Natus RetCam Envision, 130° FOV · wide-field fundus photograph of an infant: 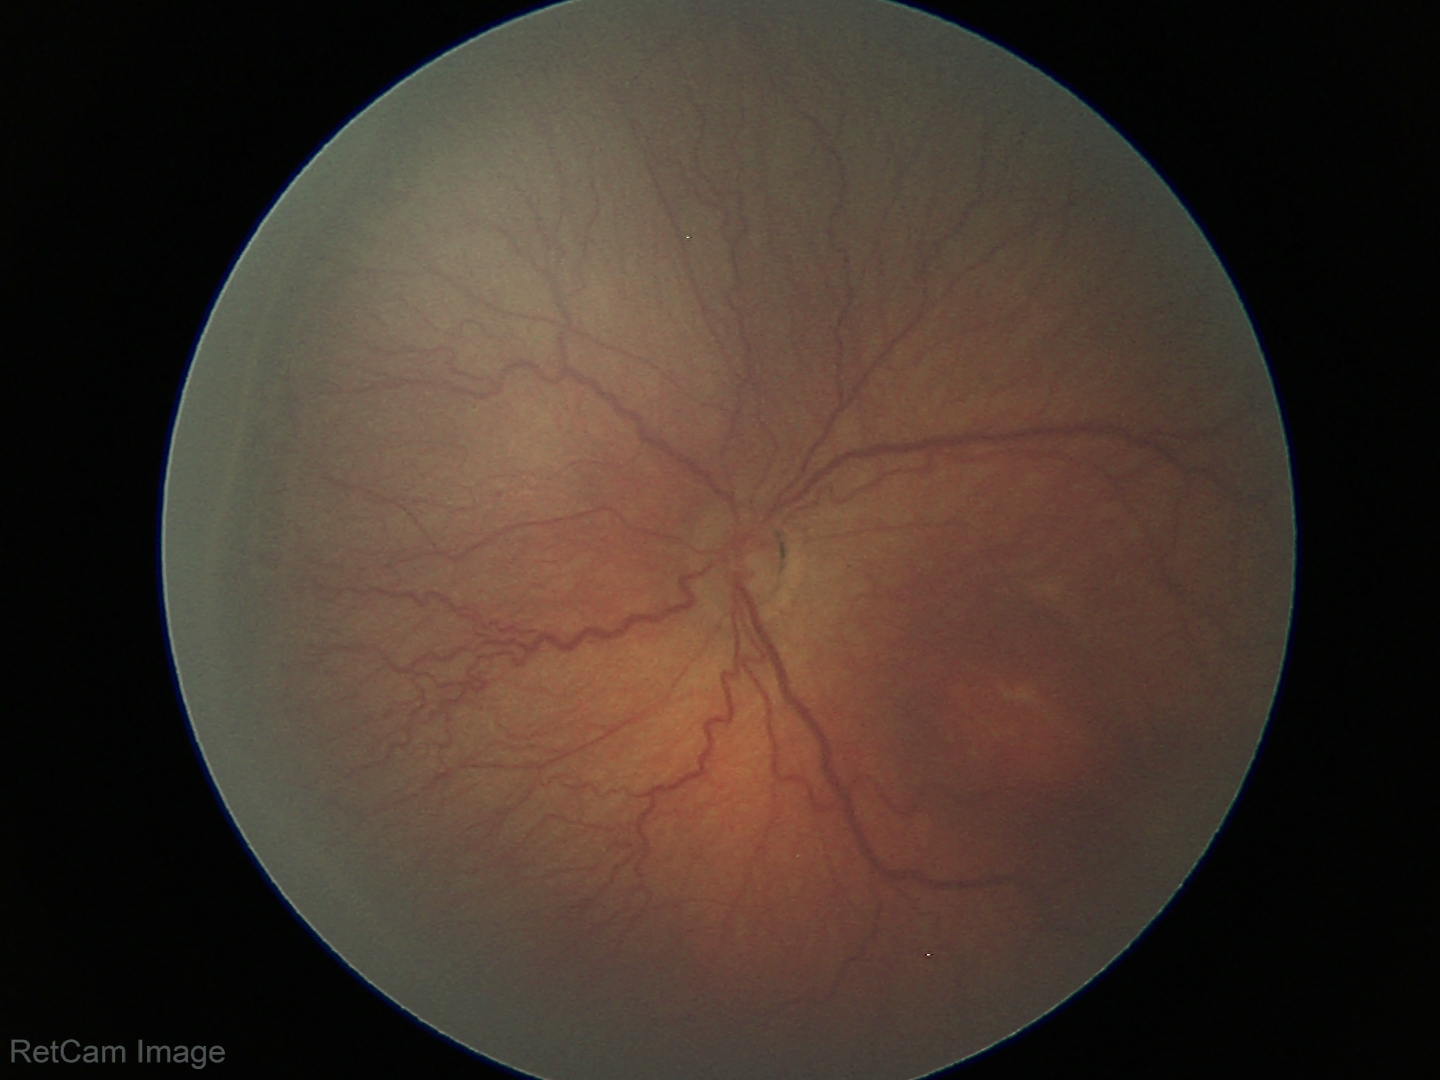 Diagnosis from this screening exam: retinopathy of prematurity (ROP) stage 3 — ridge with extraretinal fibrovascular proliferation. No plus disease.